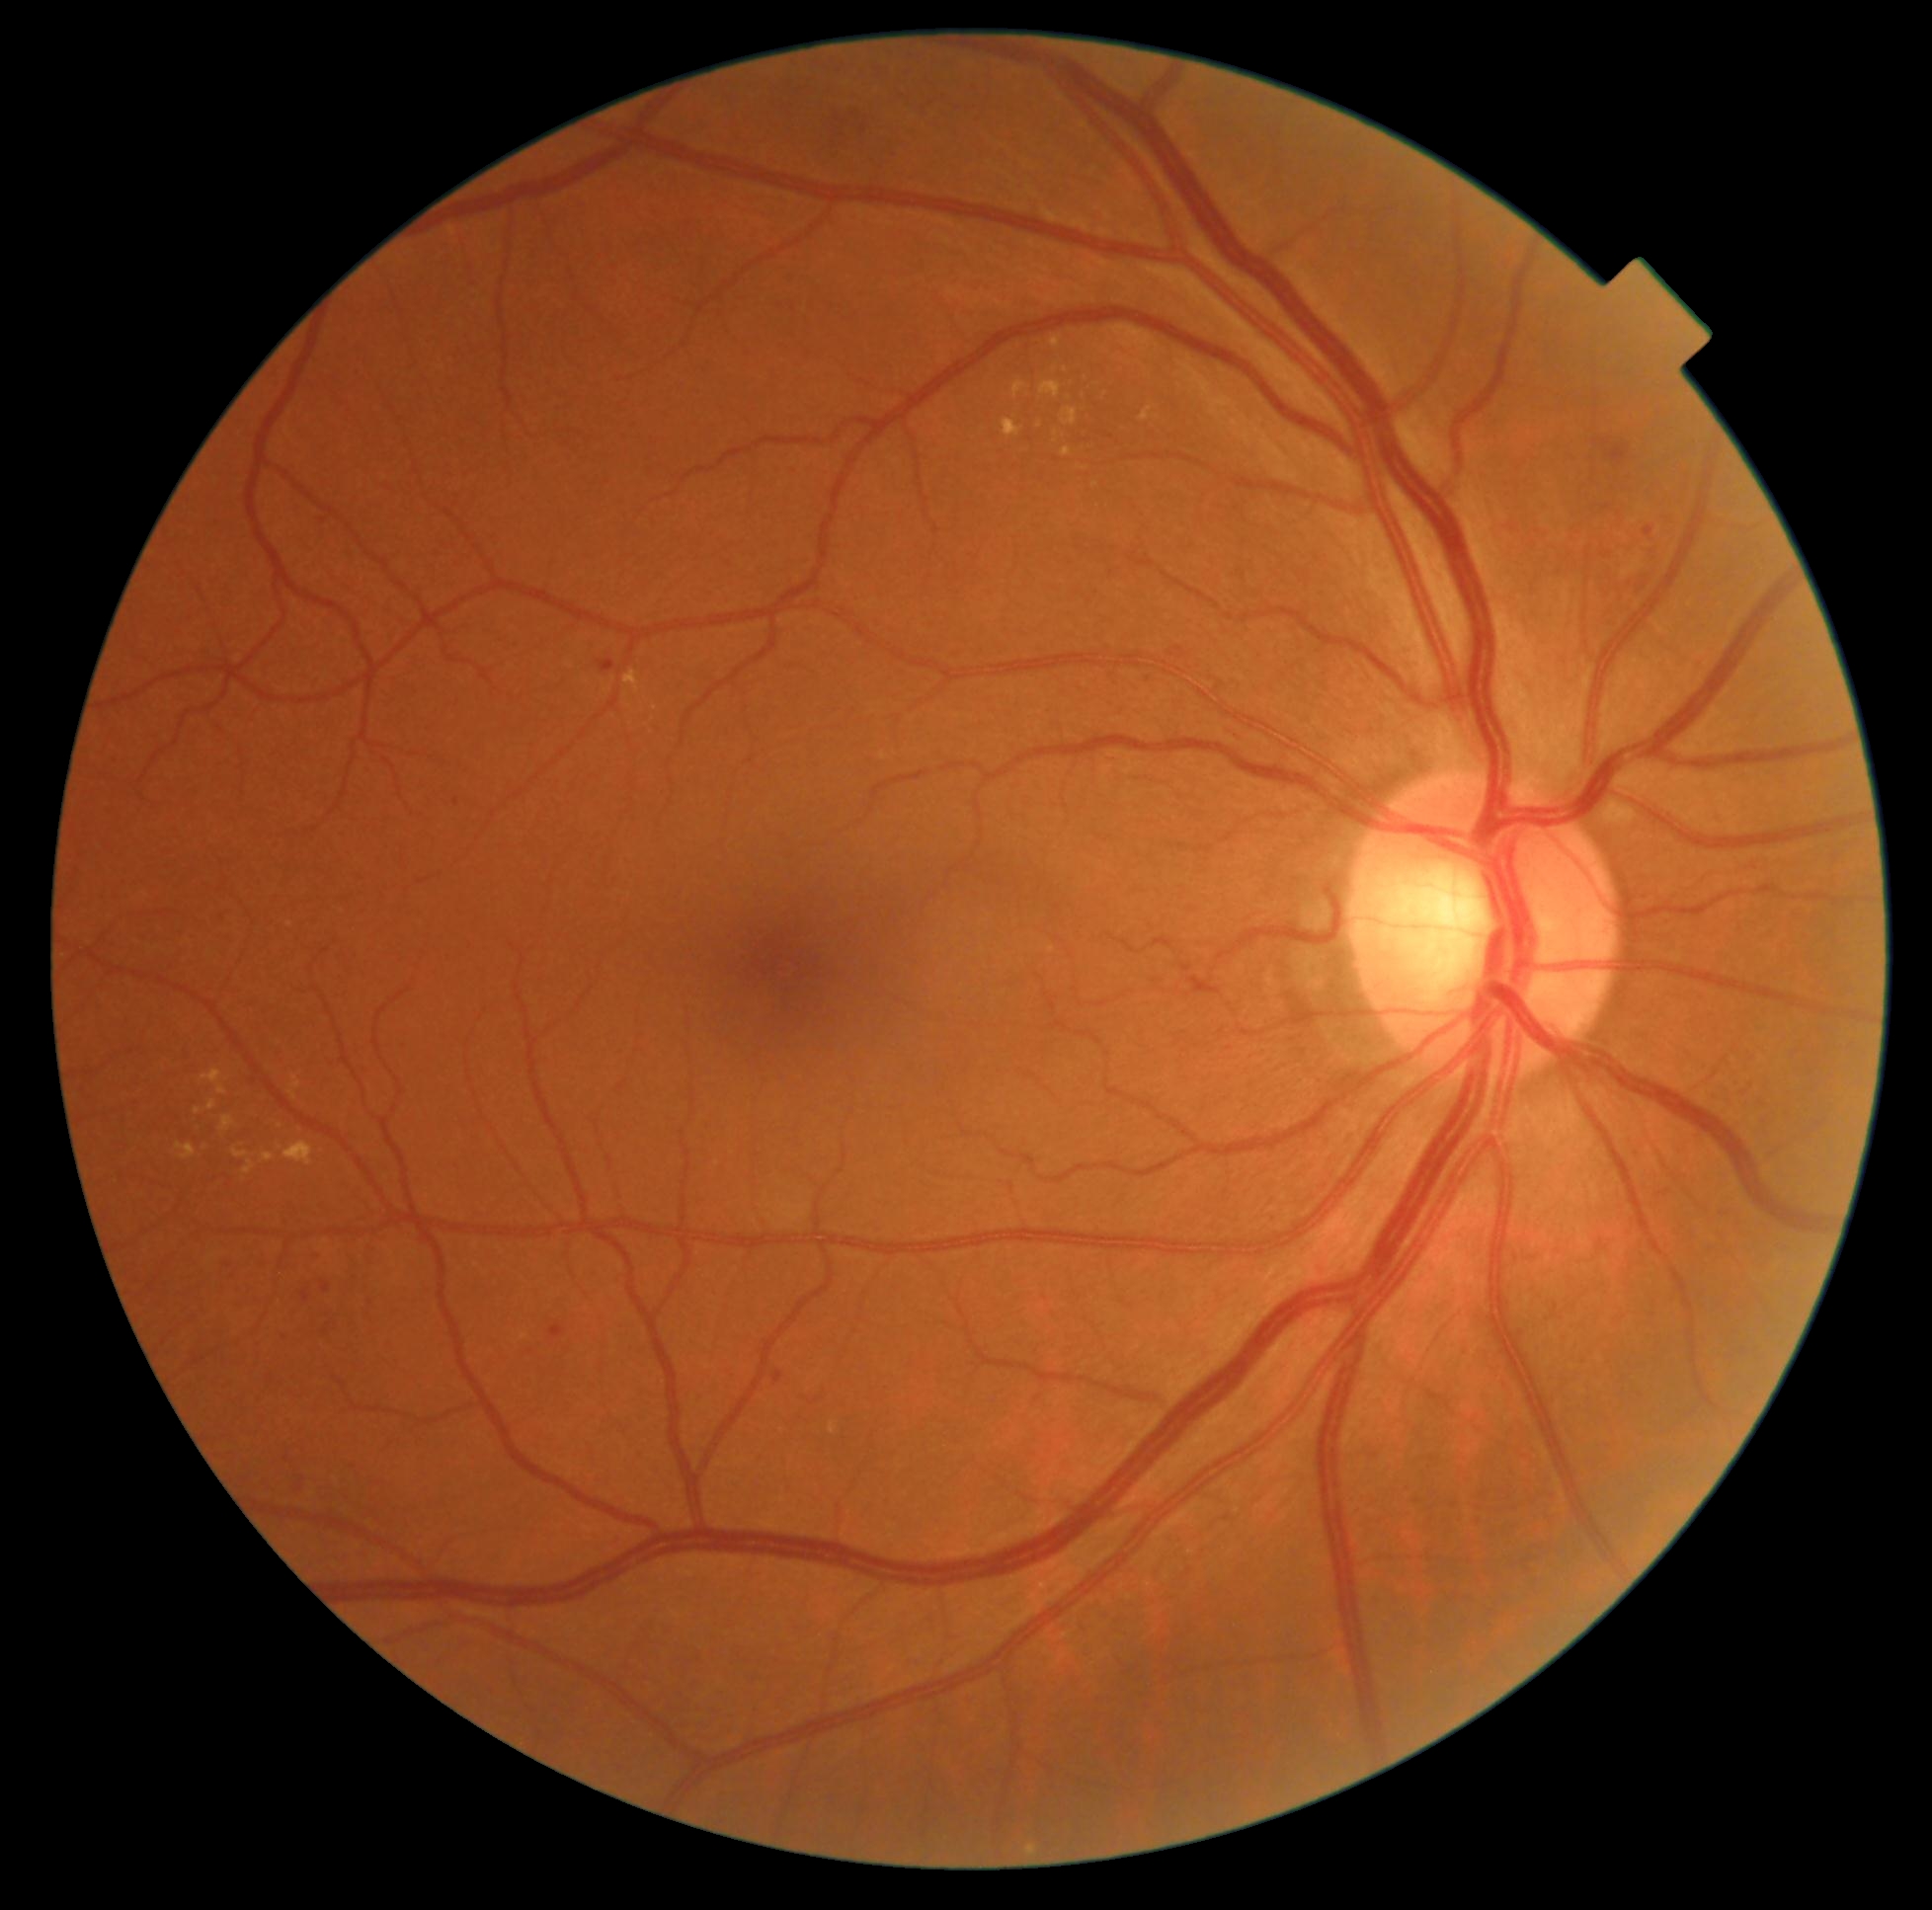 DR stage: moderate NPDR (grade 2).